DR severity per modified Davis staging. 45 degree fundus photograph. CFP: 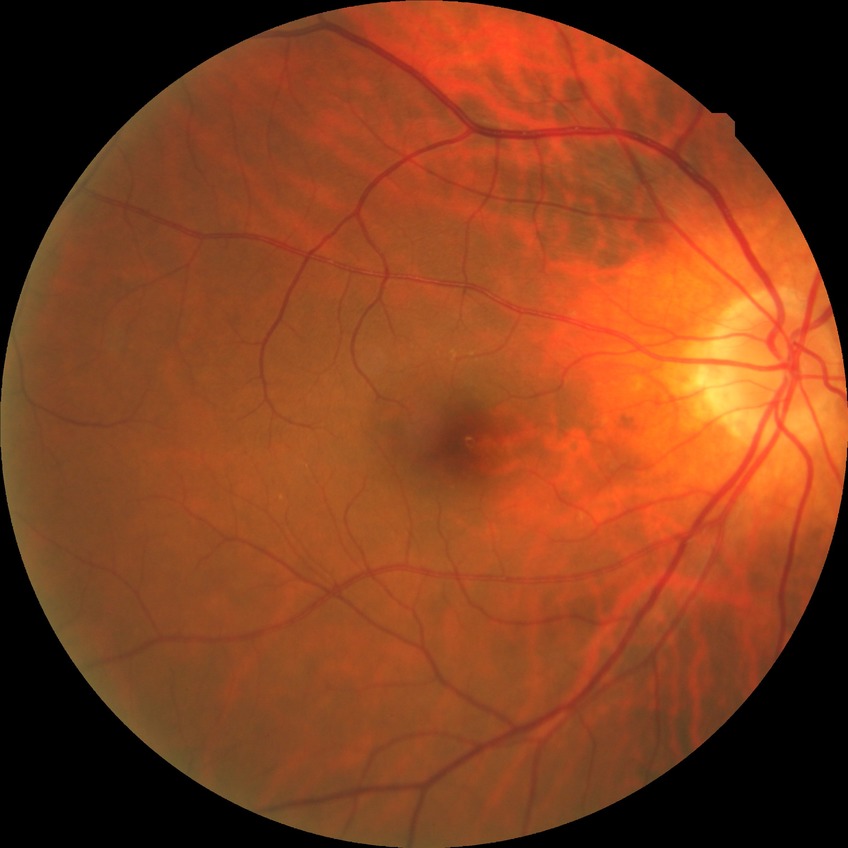 diabetic retinopathy (DR): NDR (no diabetic retinopathy).